Pediatric wide-field fundus photograph
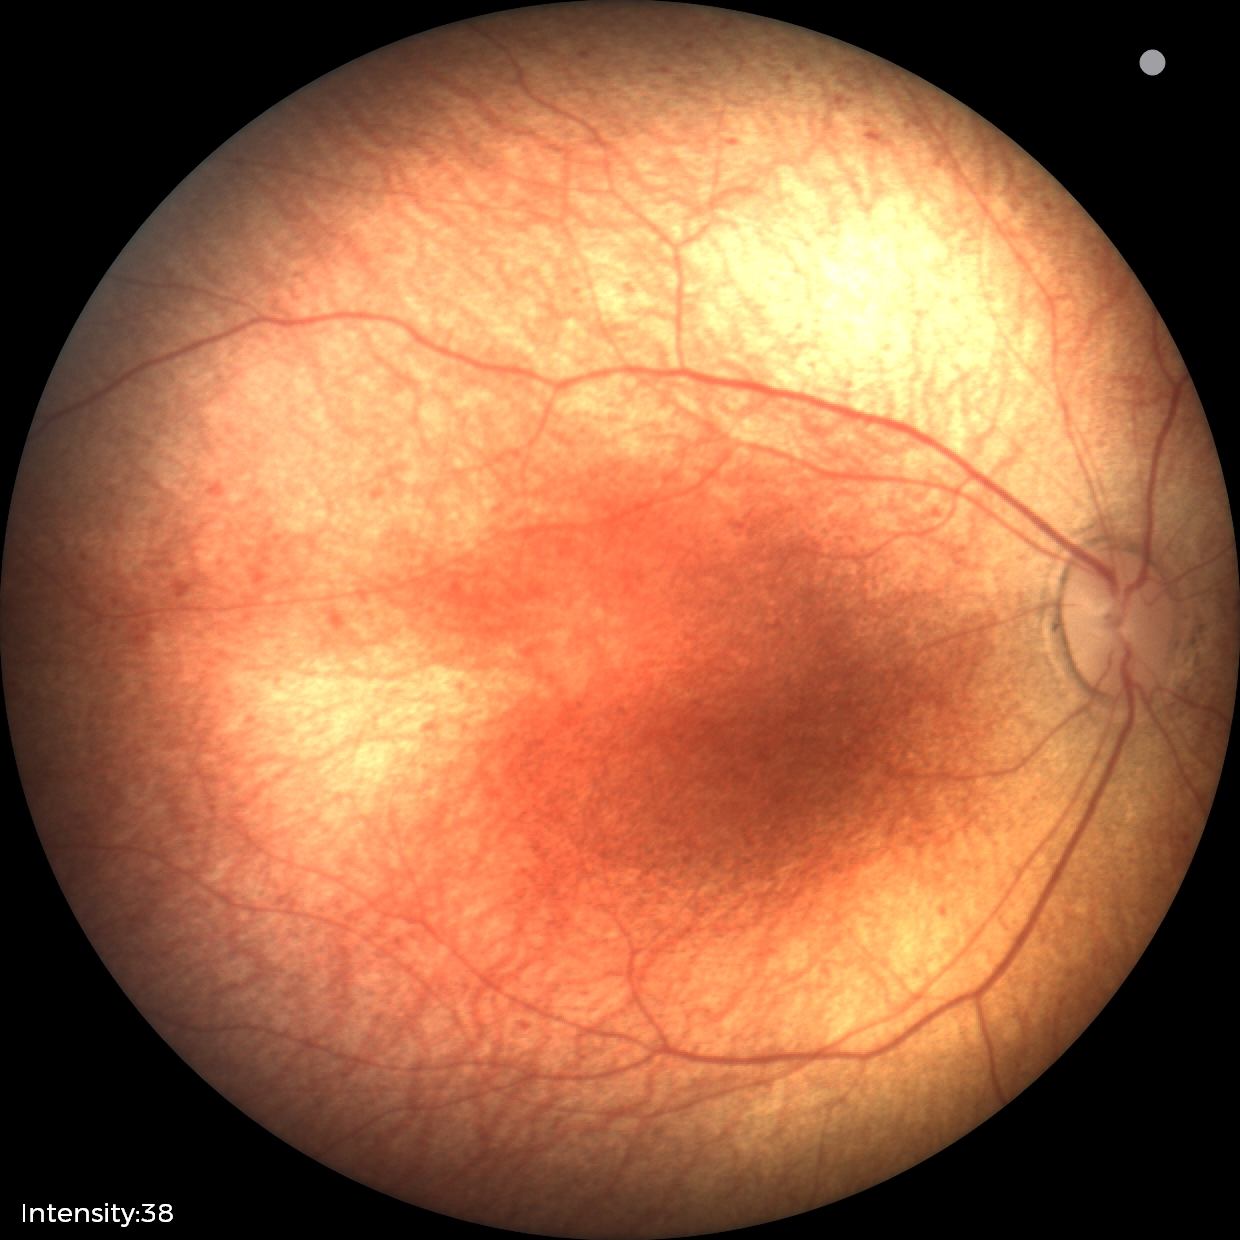 Screening examination diagnosed as physiological.